848x848px · modified Davis classification · NIDEK AFC-230 fundus camera:
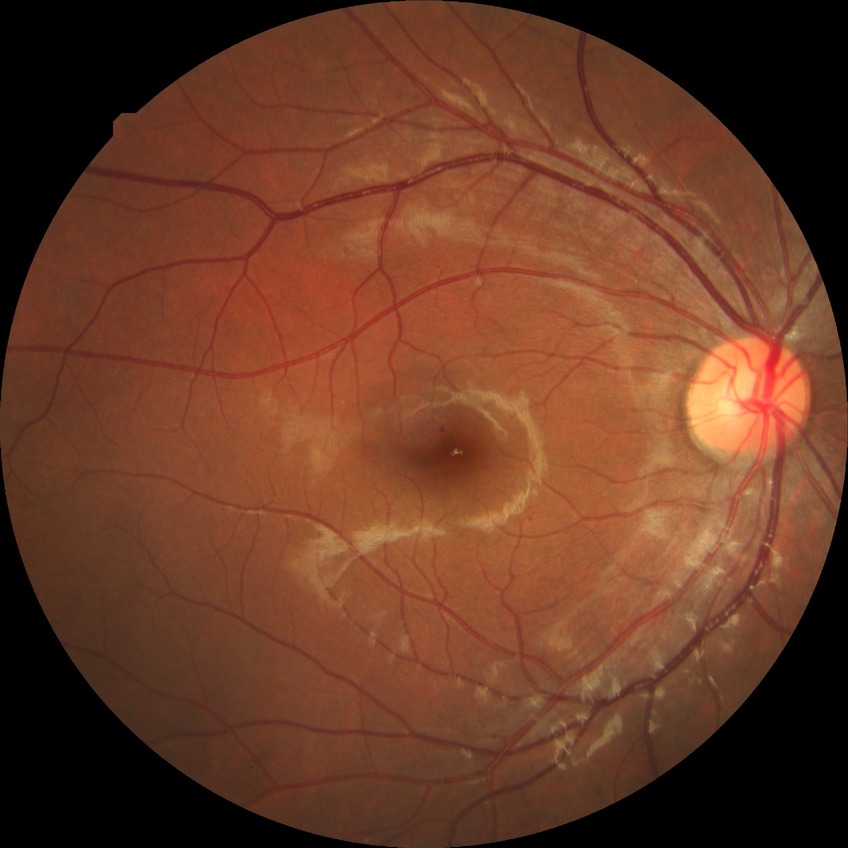 Modified Davis classification: simple diabetic retinopathy.